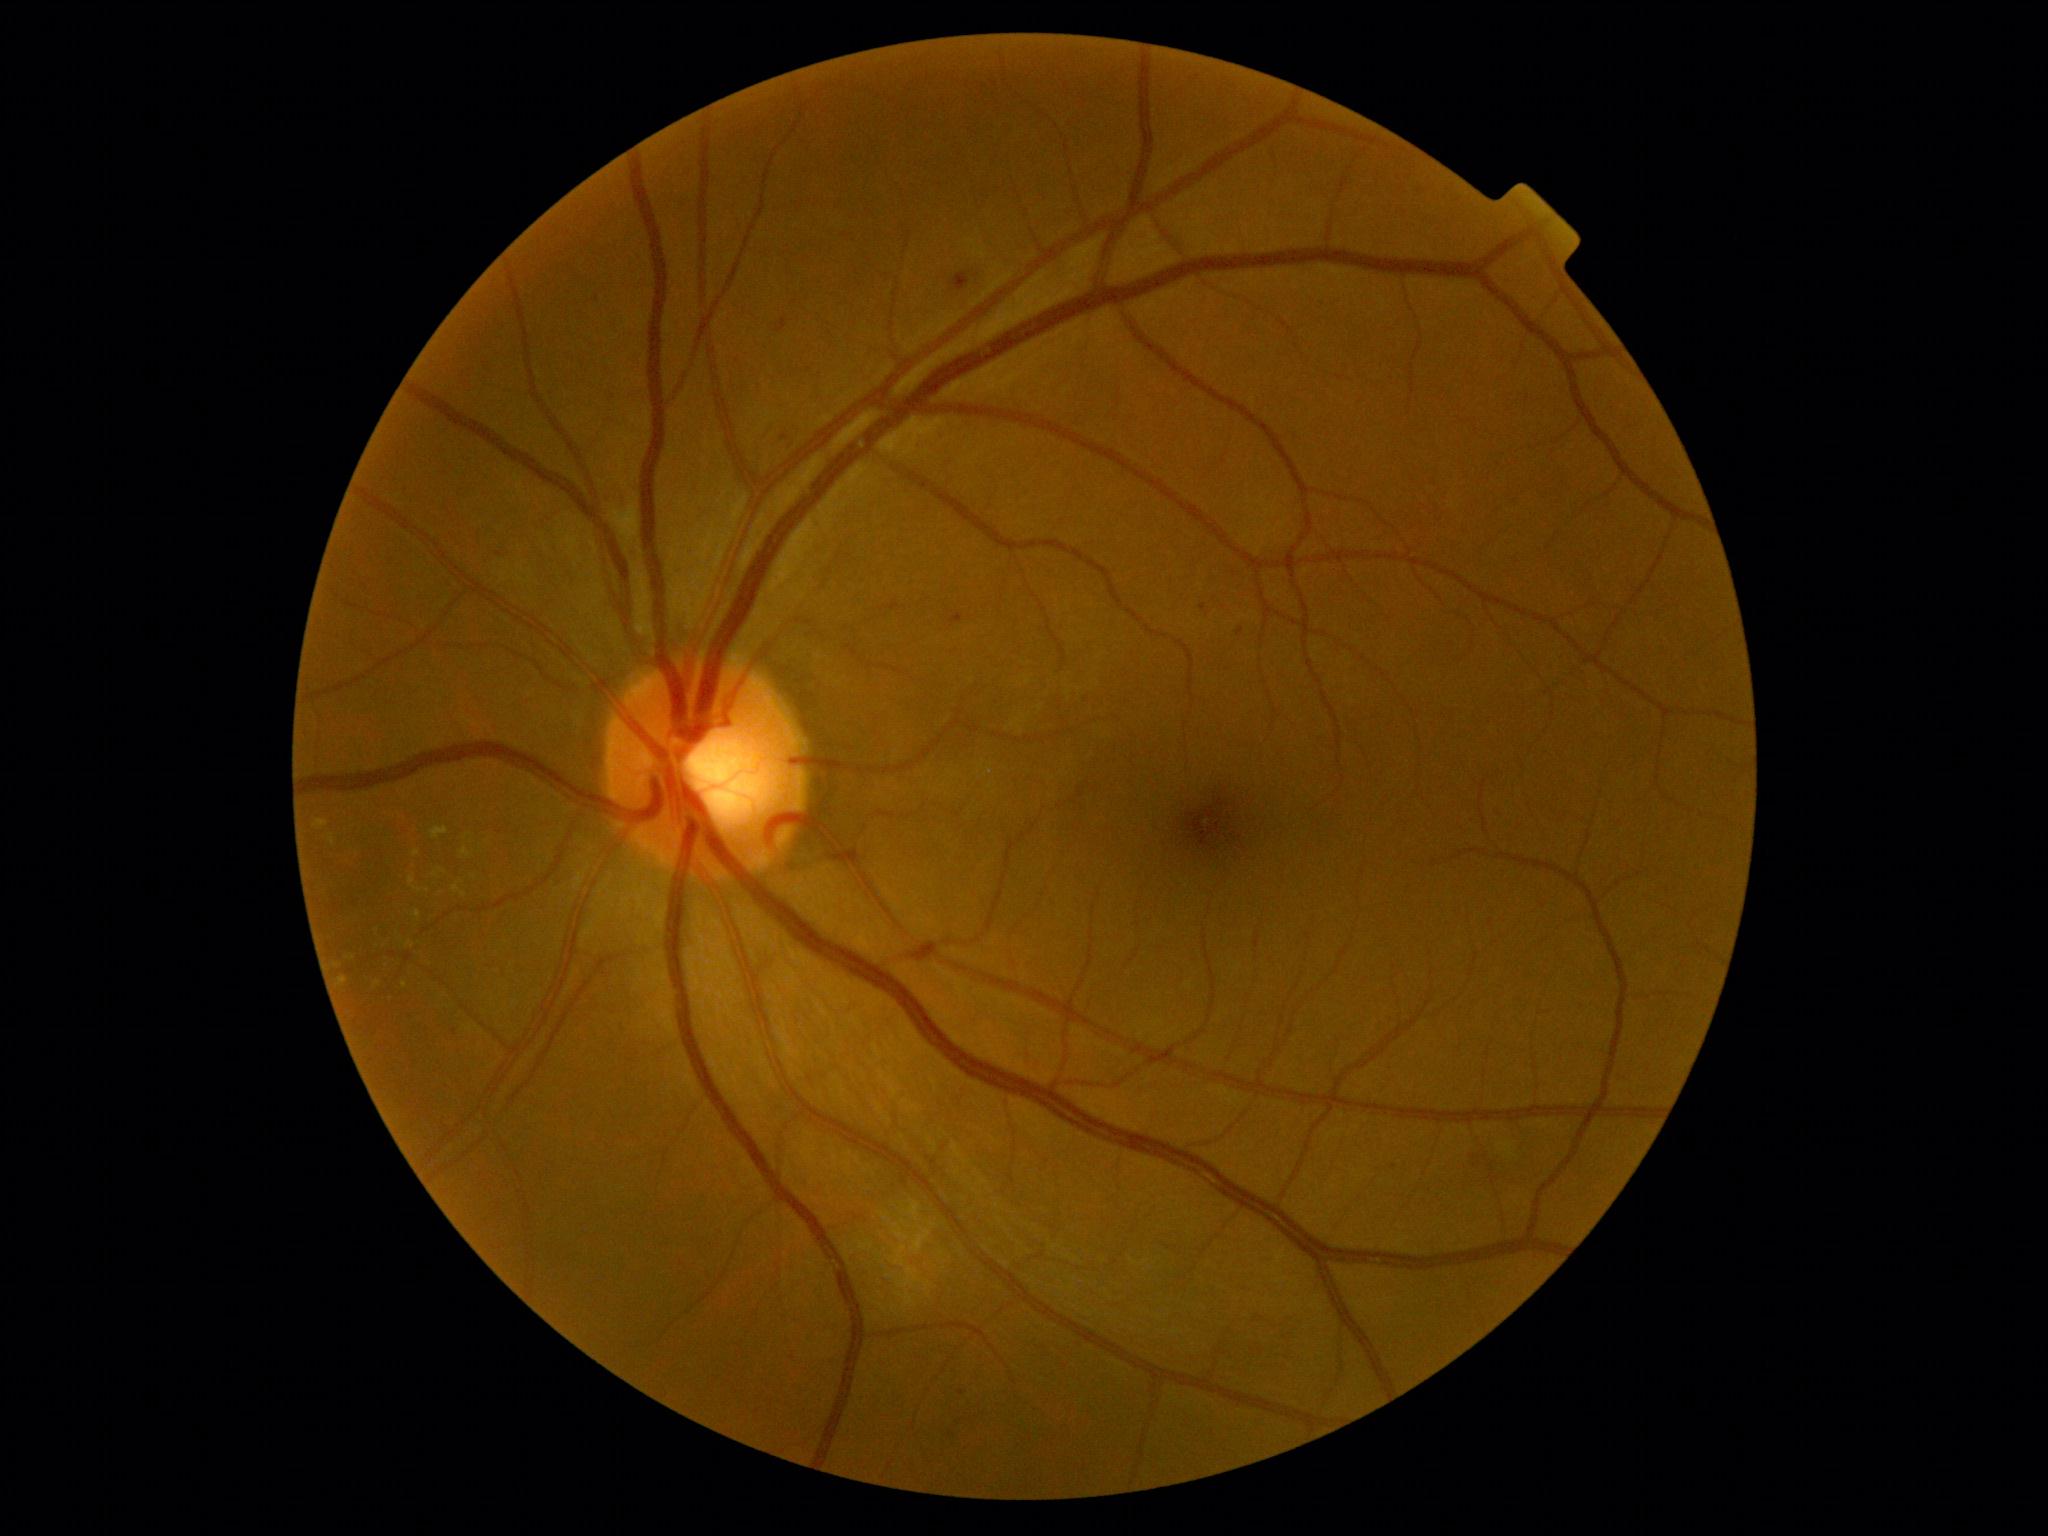

Retinopathy grade: moderate non-proliferative diabetic retinopathy (2) — more than just microaneurysms but less than severe NPDR.